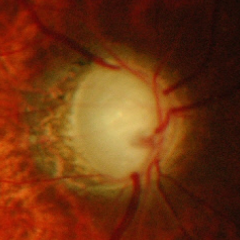

Glaucoma diagnosis = advanced glaucoma. Diagnostic criteria: near-total cupping of the optic nerve head, with or without severe visual field loss within the central 10 degrees of fixation.